2352x1568; 45° field of view.
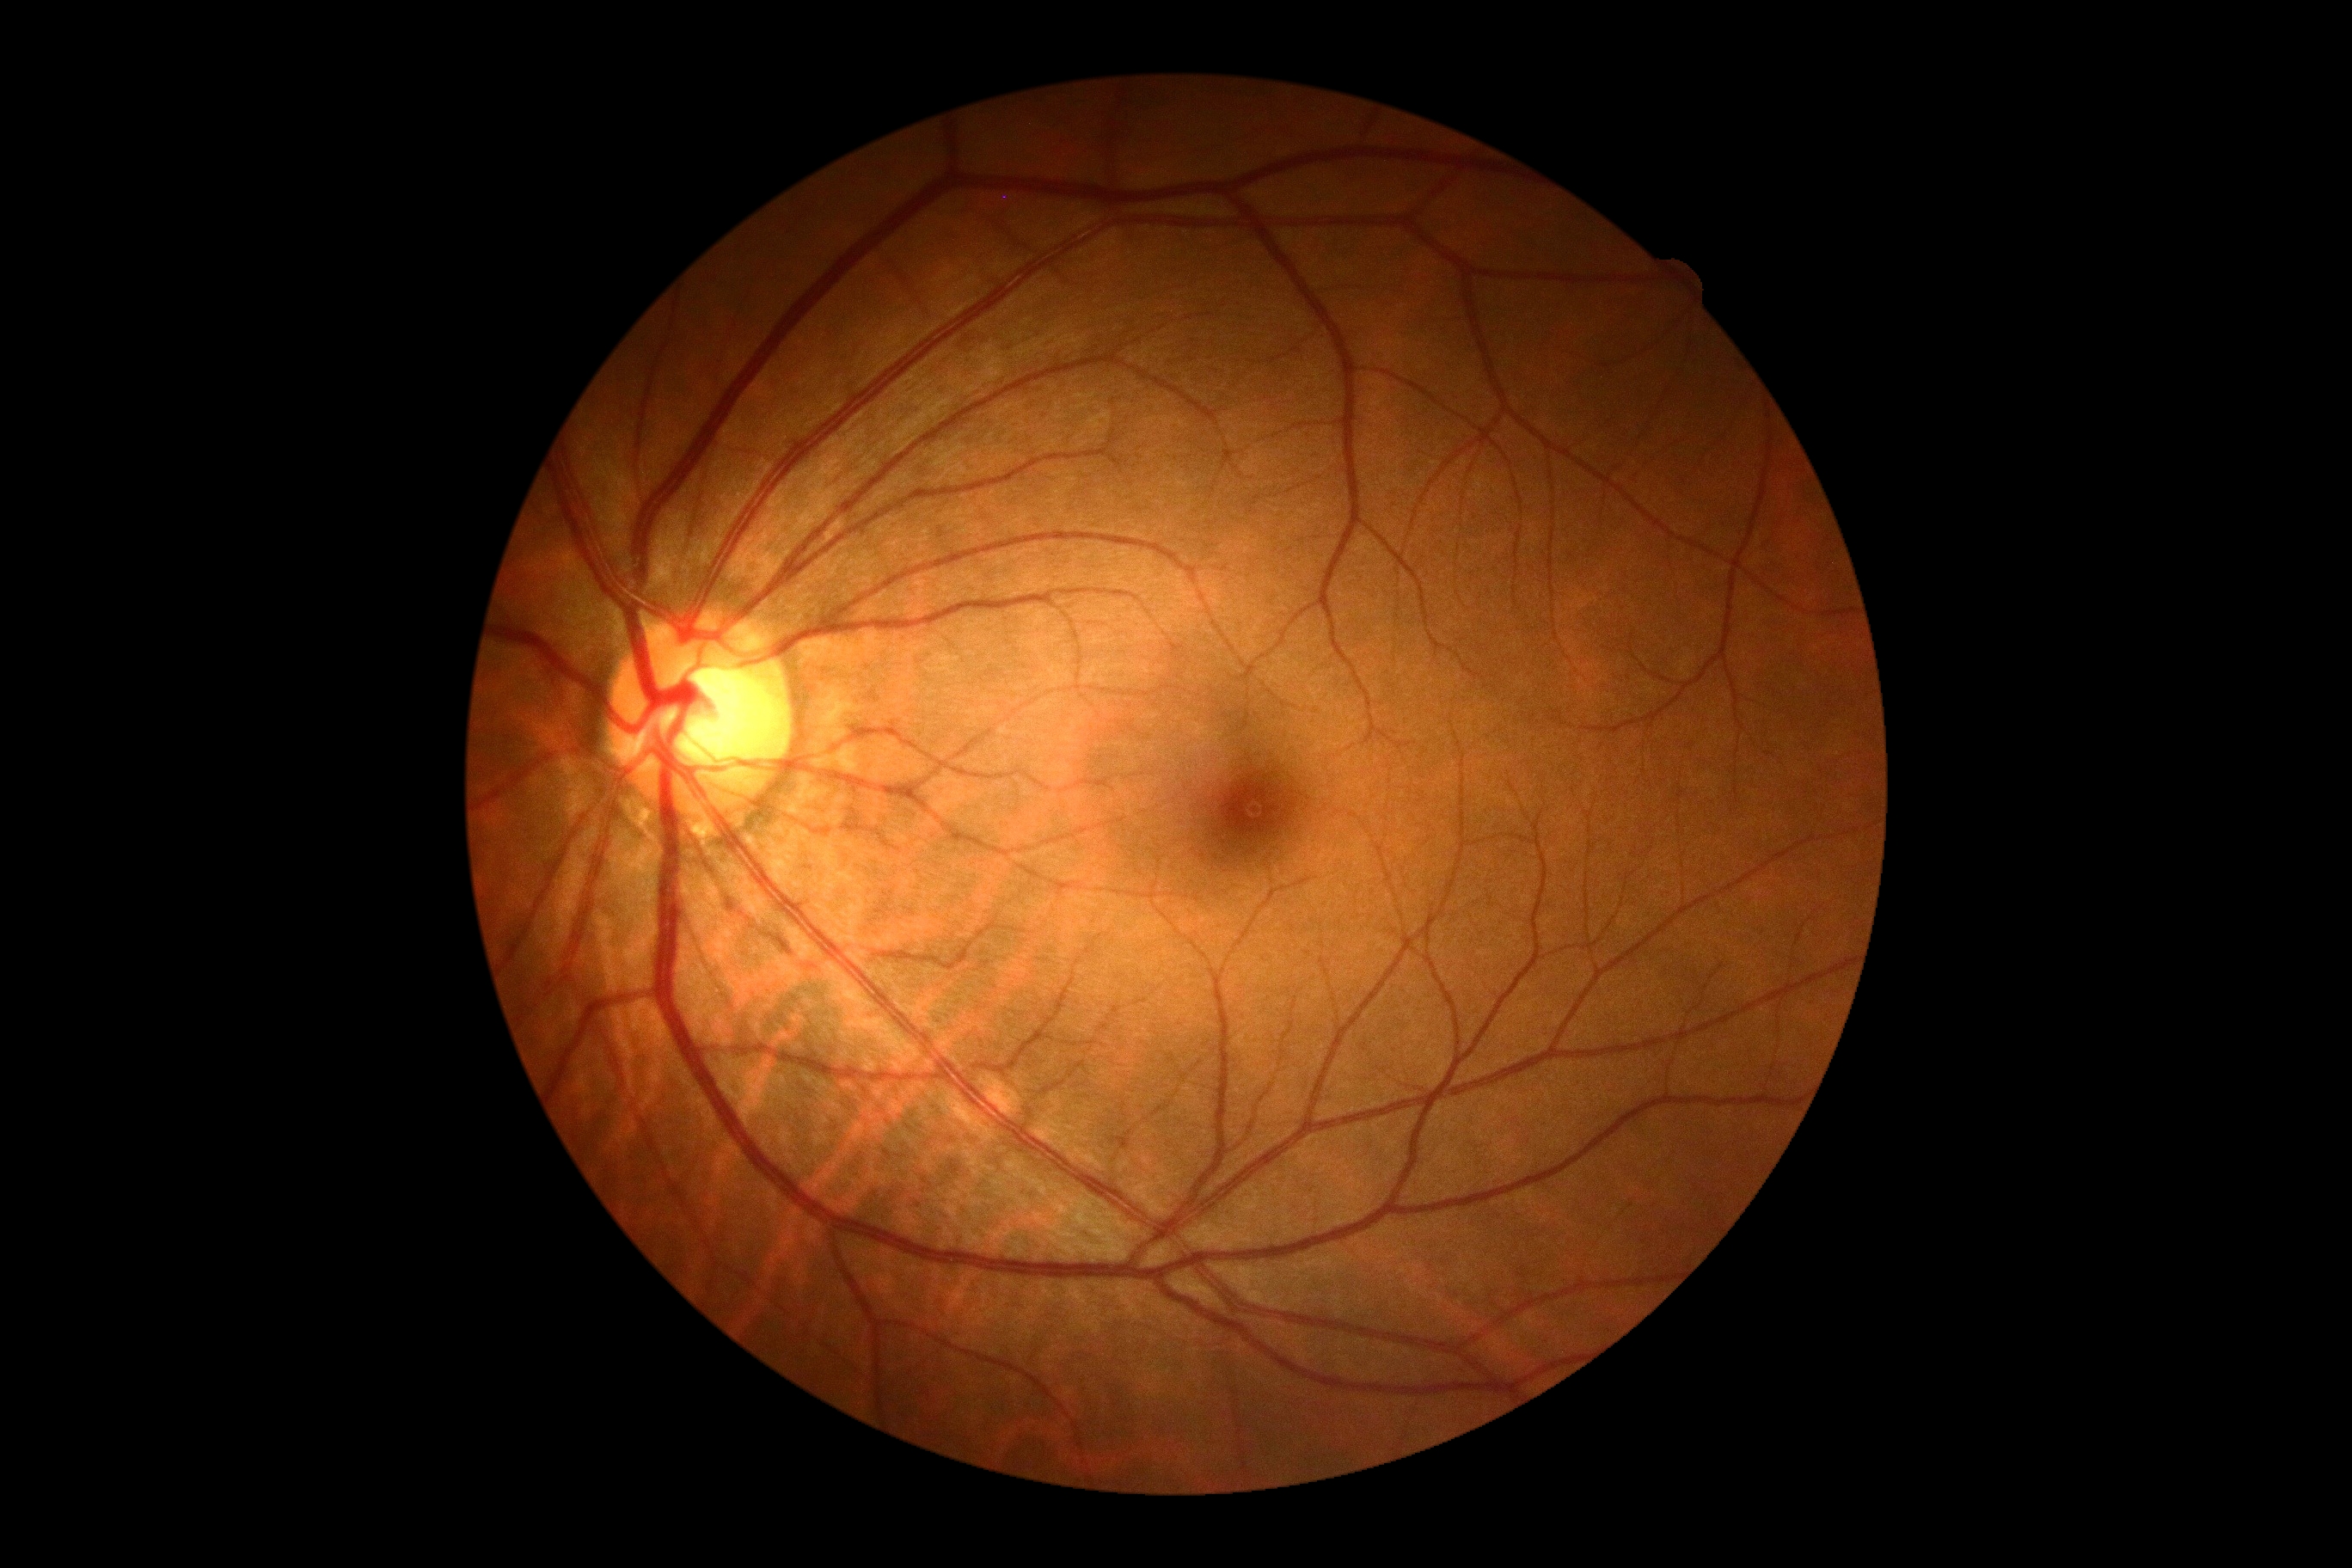 Annotations:
– diabetic retinopathy grade: no apparent diabetic retinopathy (0)